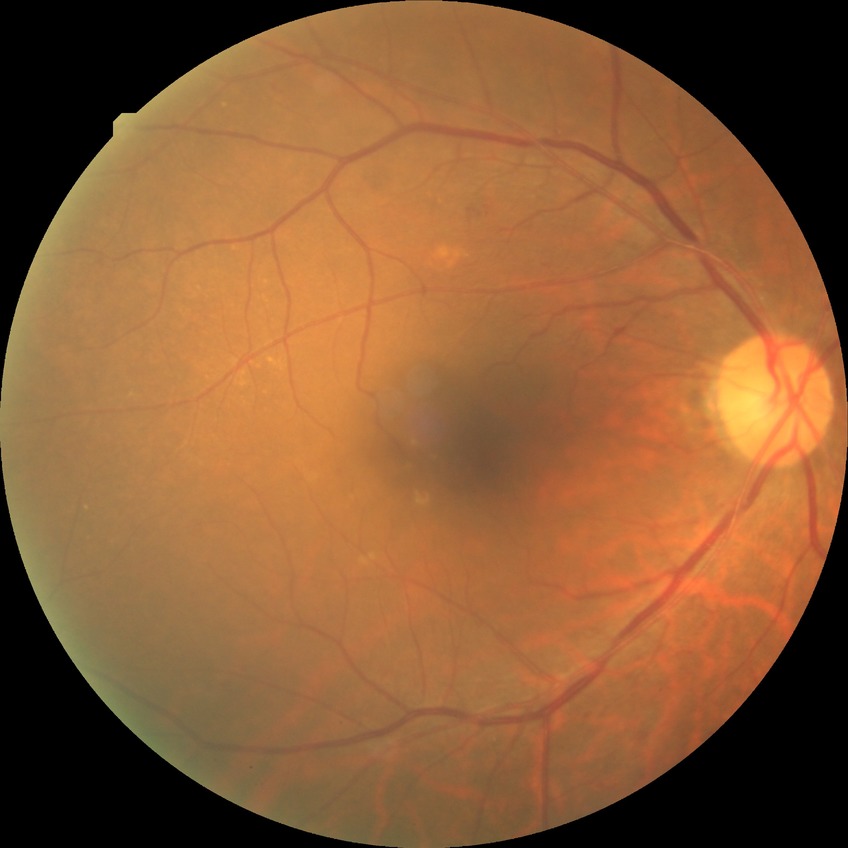 The retinopathy is classified as non-proliferative diabetic retinopathy.
Diabetic retinopathy (DR) is SDR (simple diabetic retinopathy).